100° field of view (Phoenix ICON); wide-field fundus photograph of an infant; 1240x1240: 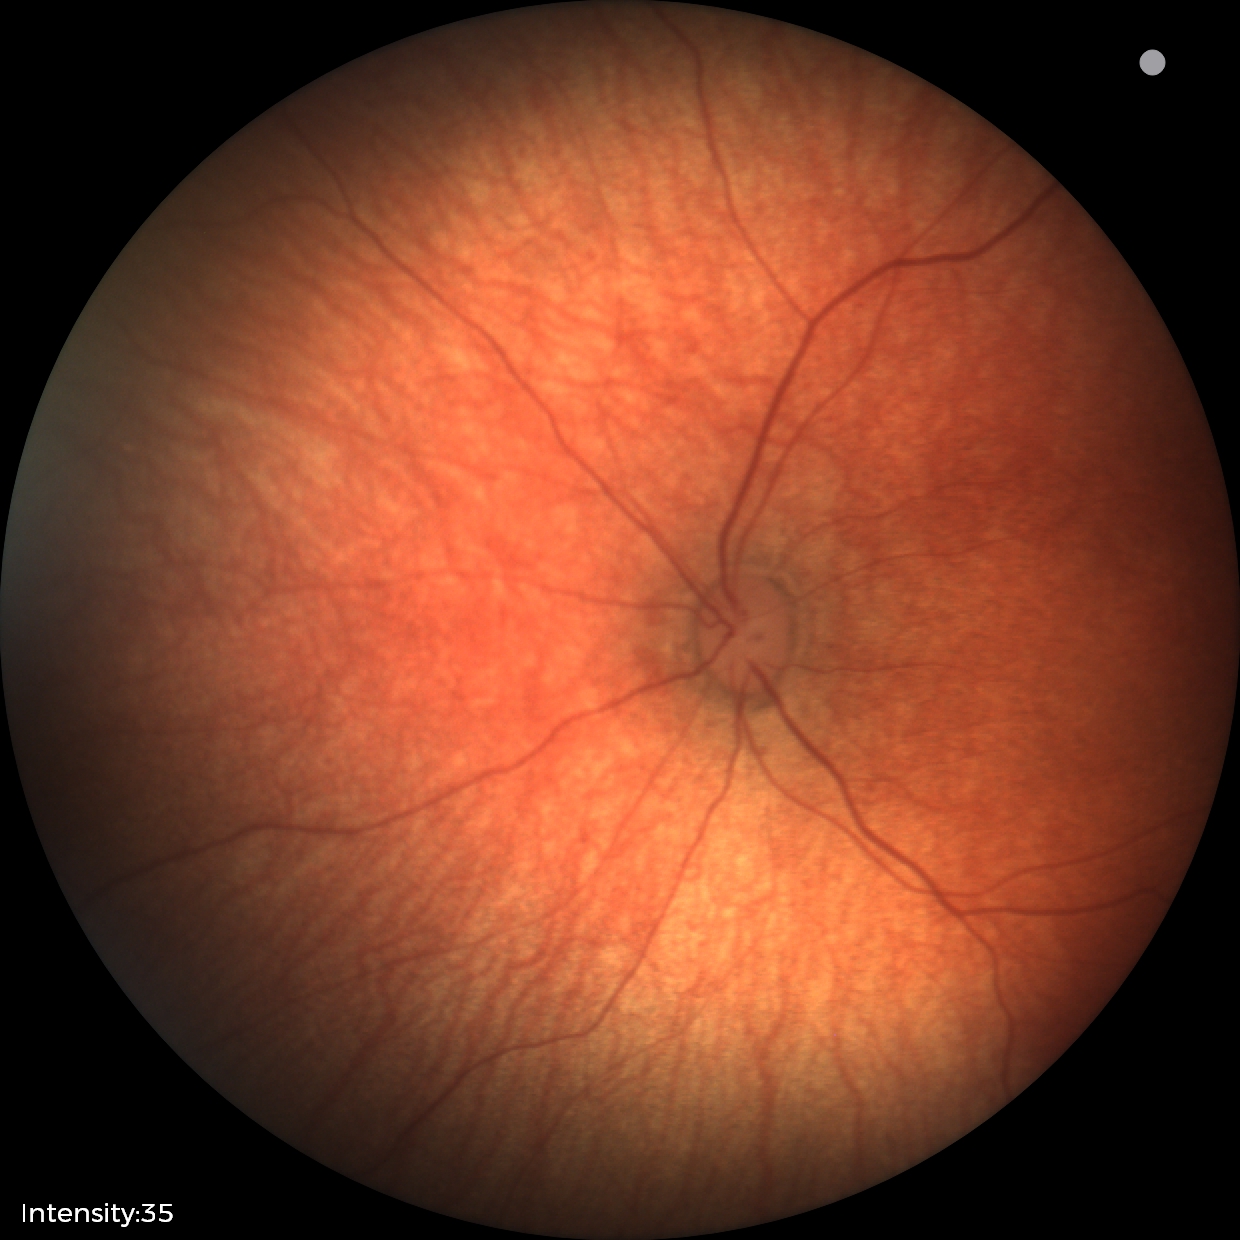 Physiological retinal appearance for postconceptual age.